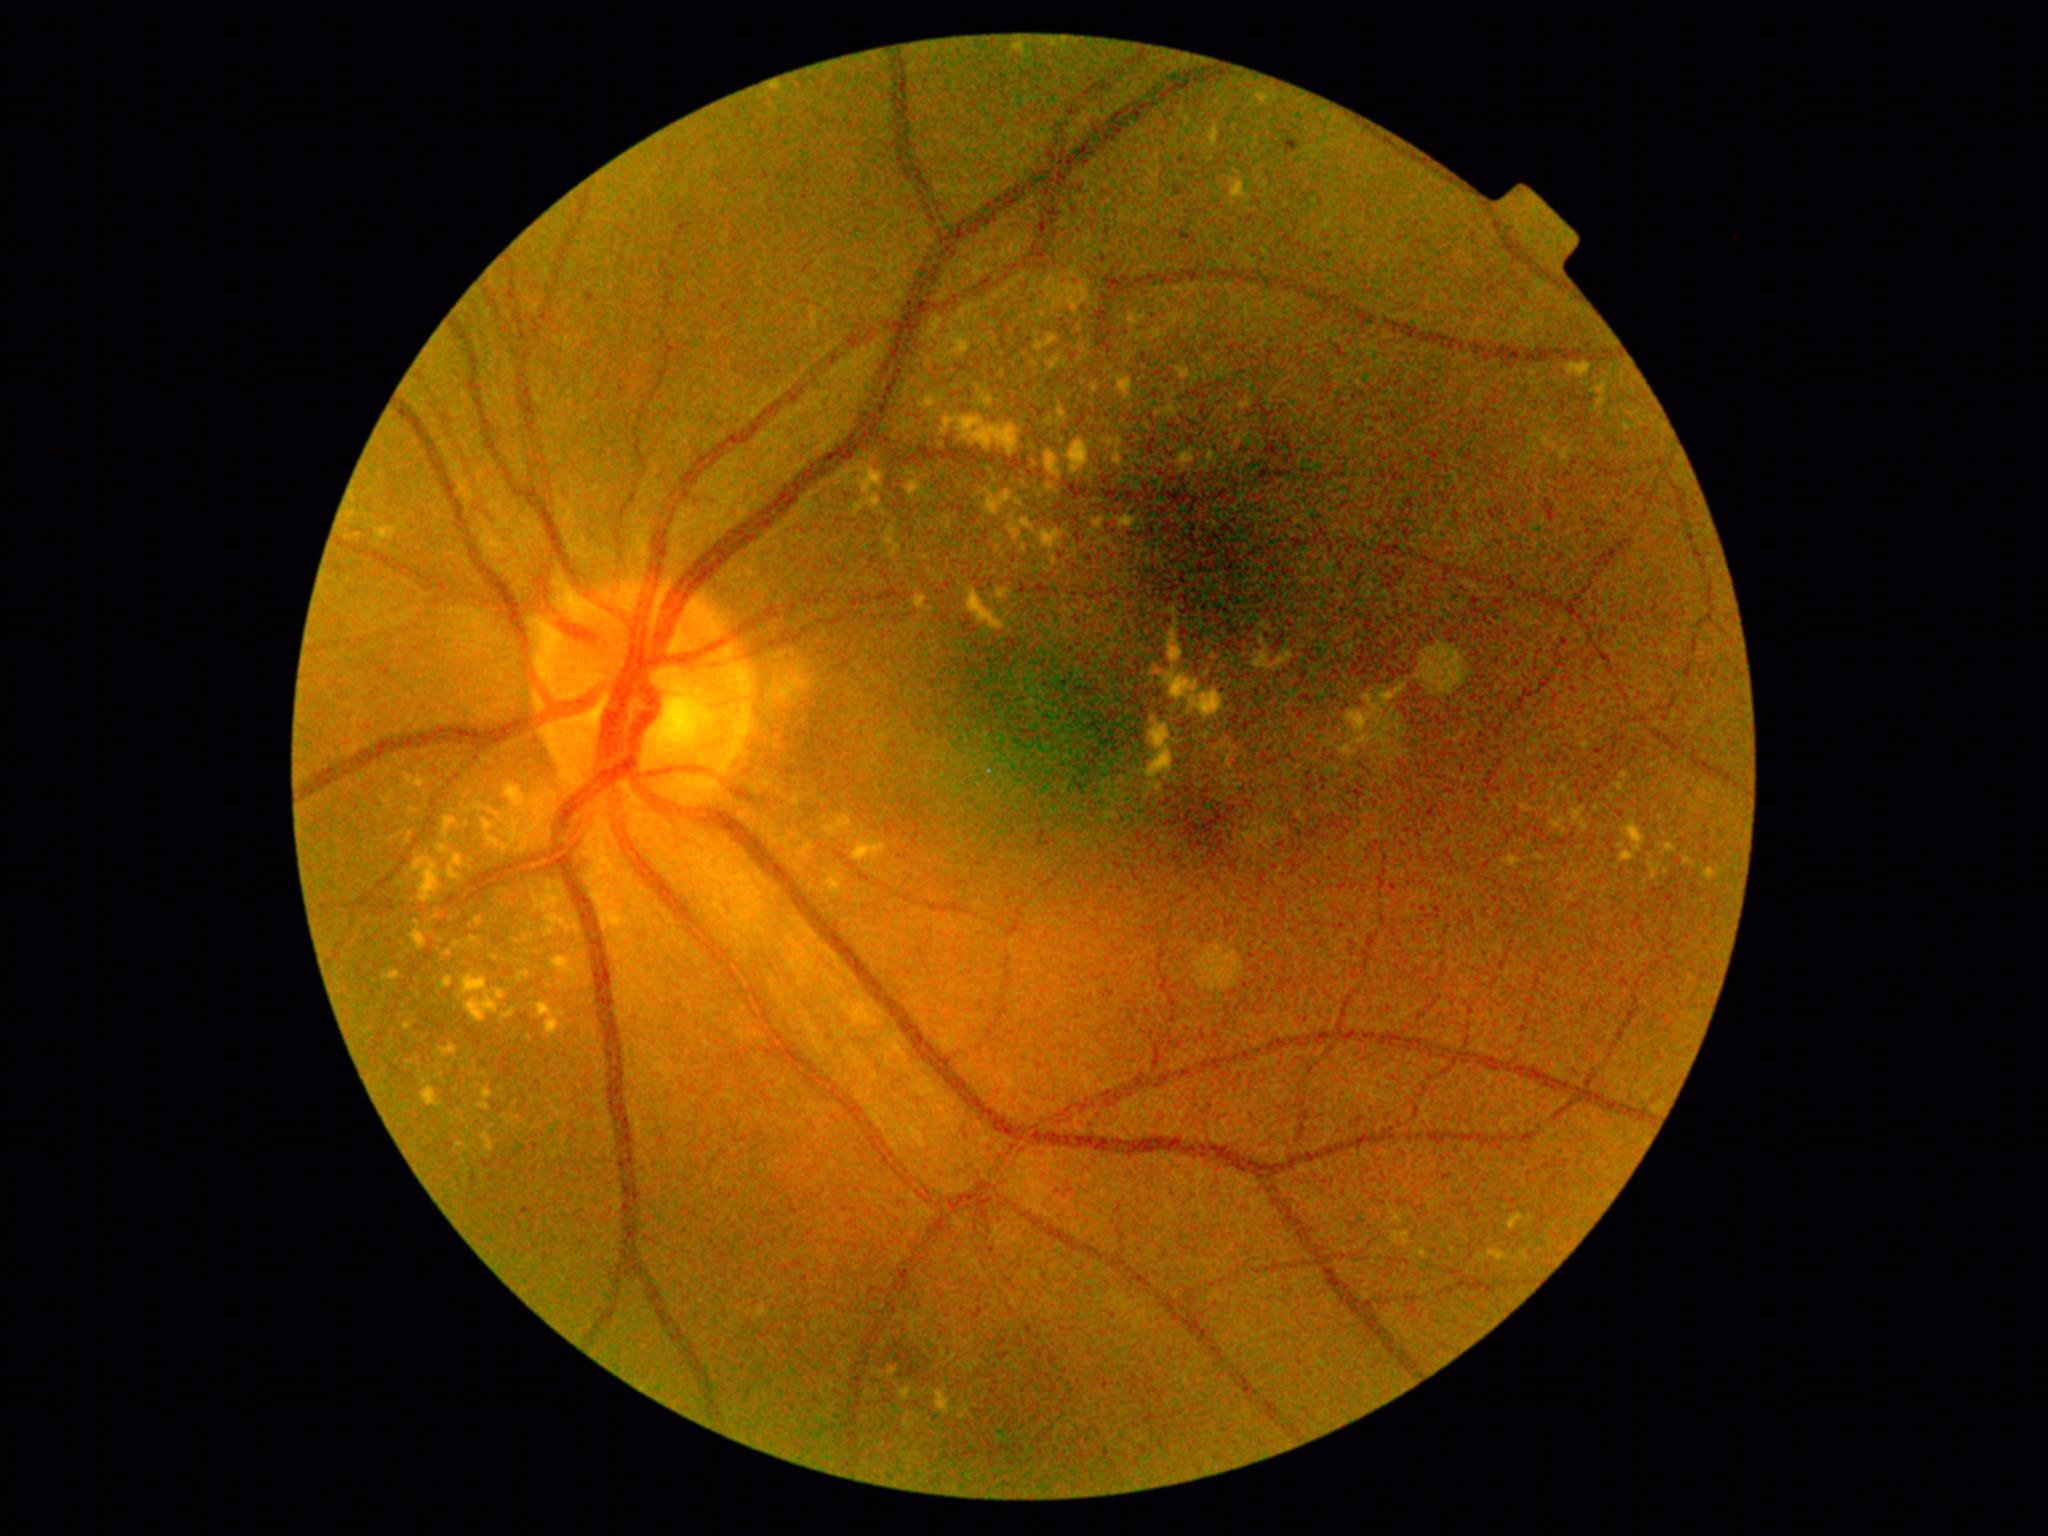
Diabetic retinopathy: grade 2 (moderate NPDR)
Lesions identified (partial list):
hard exudates (more not shown): bbox=(870, 473, 880, 484) | bbox=(1047, 360, 1059, 368) | bbox=(937, 1394, 950, 1411) | bbox=(414, 859, 440, 902) | bbox=(1509, 1216, 1523, 1229) | bbox=(504, 1011, 514, 1018) | bbox=(772, 85, 781, 90) | bbox=(1014, 44, 1024, 50) | bbox=(553, 957, 575, 974) | bbox=(1490, 1252, 1504, 1261) | bbox=(1047, 527, 1062, 563) | bbox=(873, 494, 880, 506)
Small hard exudates approximately at [1612,797] | [1002,596] | [478,921] | [1132,319] | [1597,809] | [1264,626]